640x480px · infant wide-field retinal image · acquired on the Clarity RetCam 3:
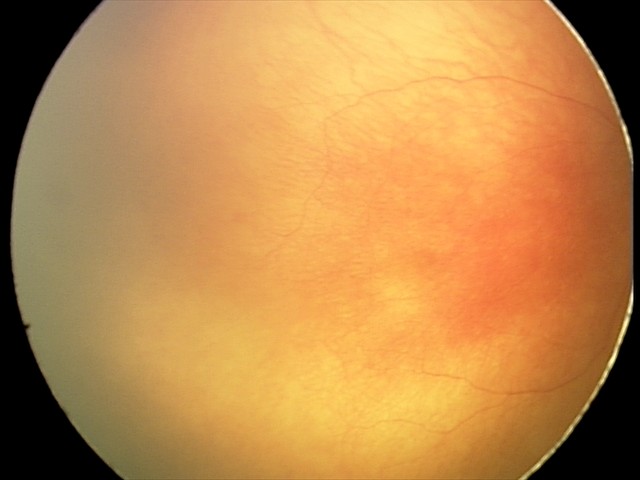

Examination diagnosed as aggressive ROP (A-ROP). Plus disease present.